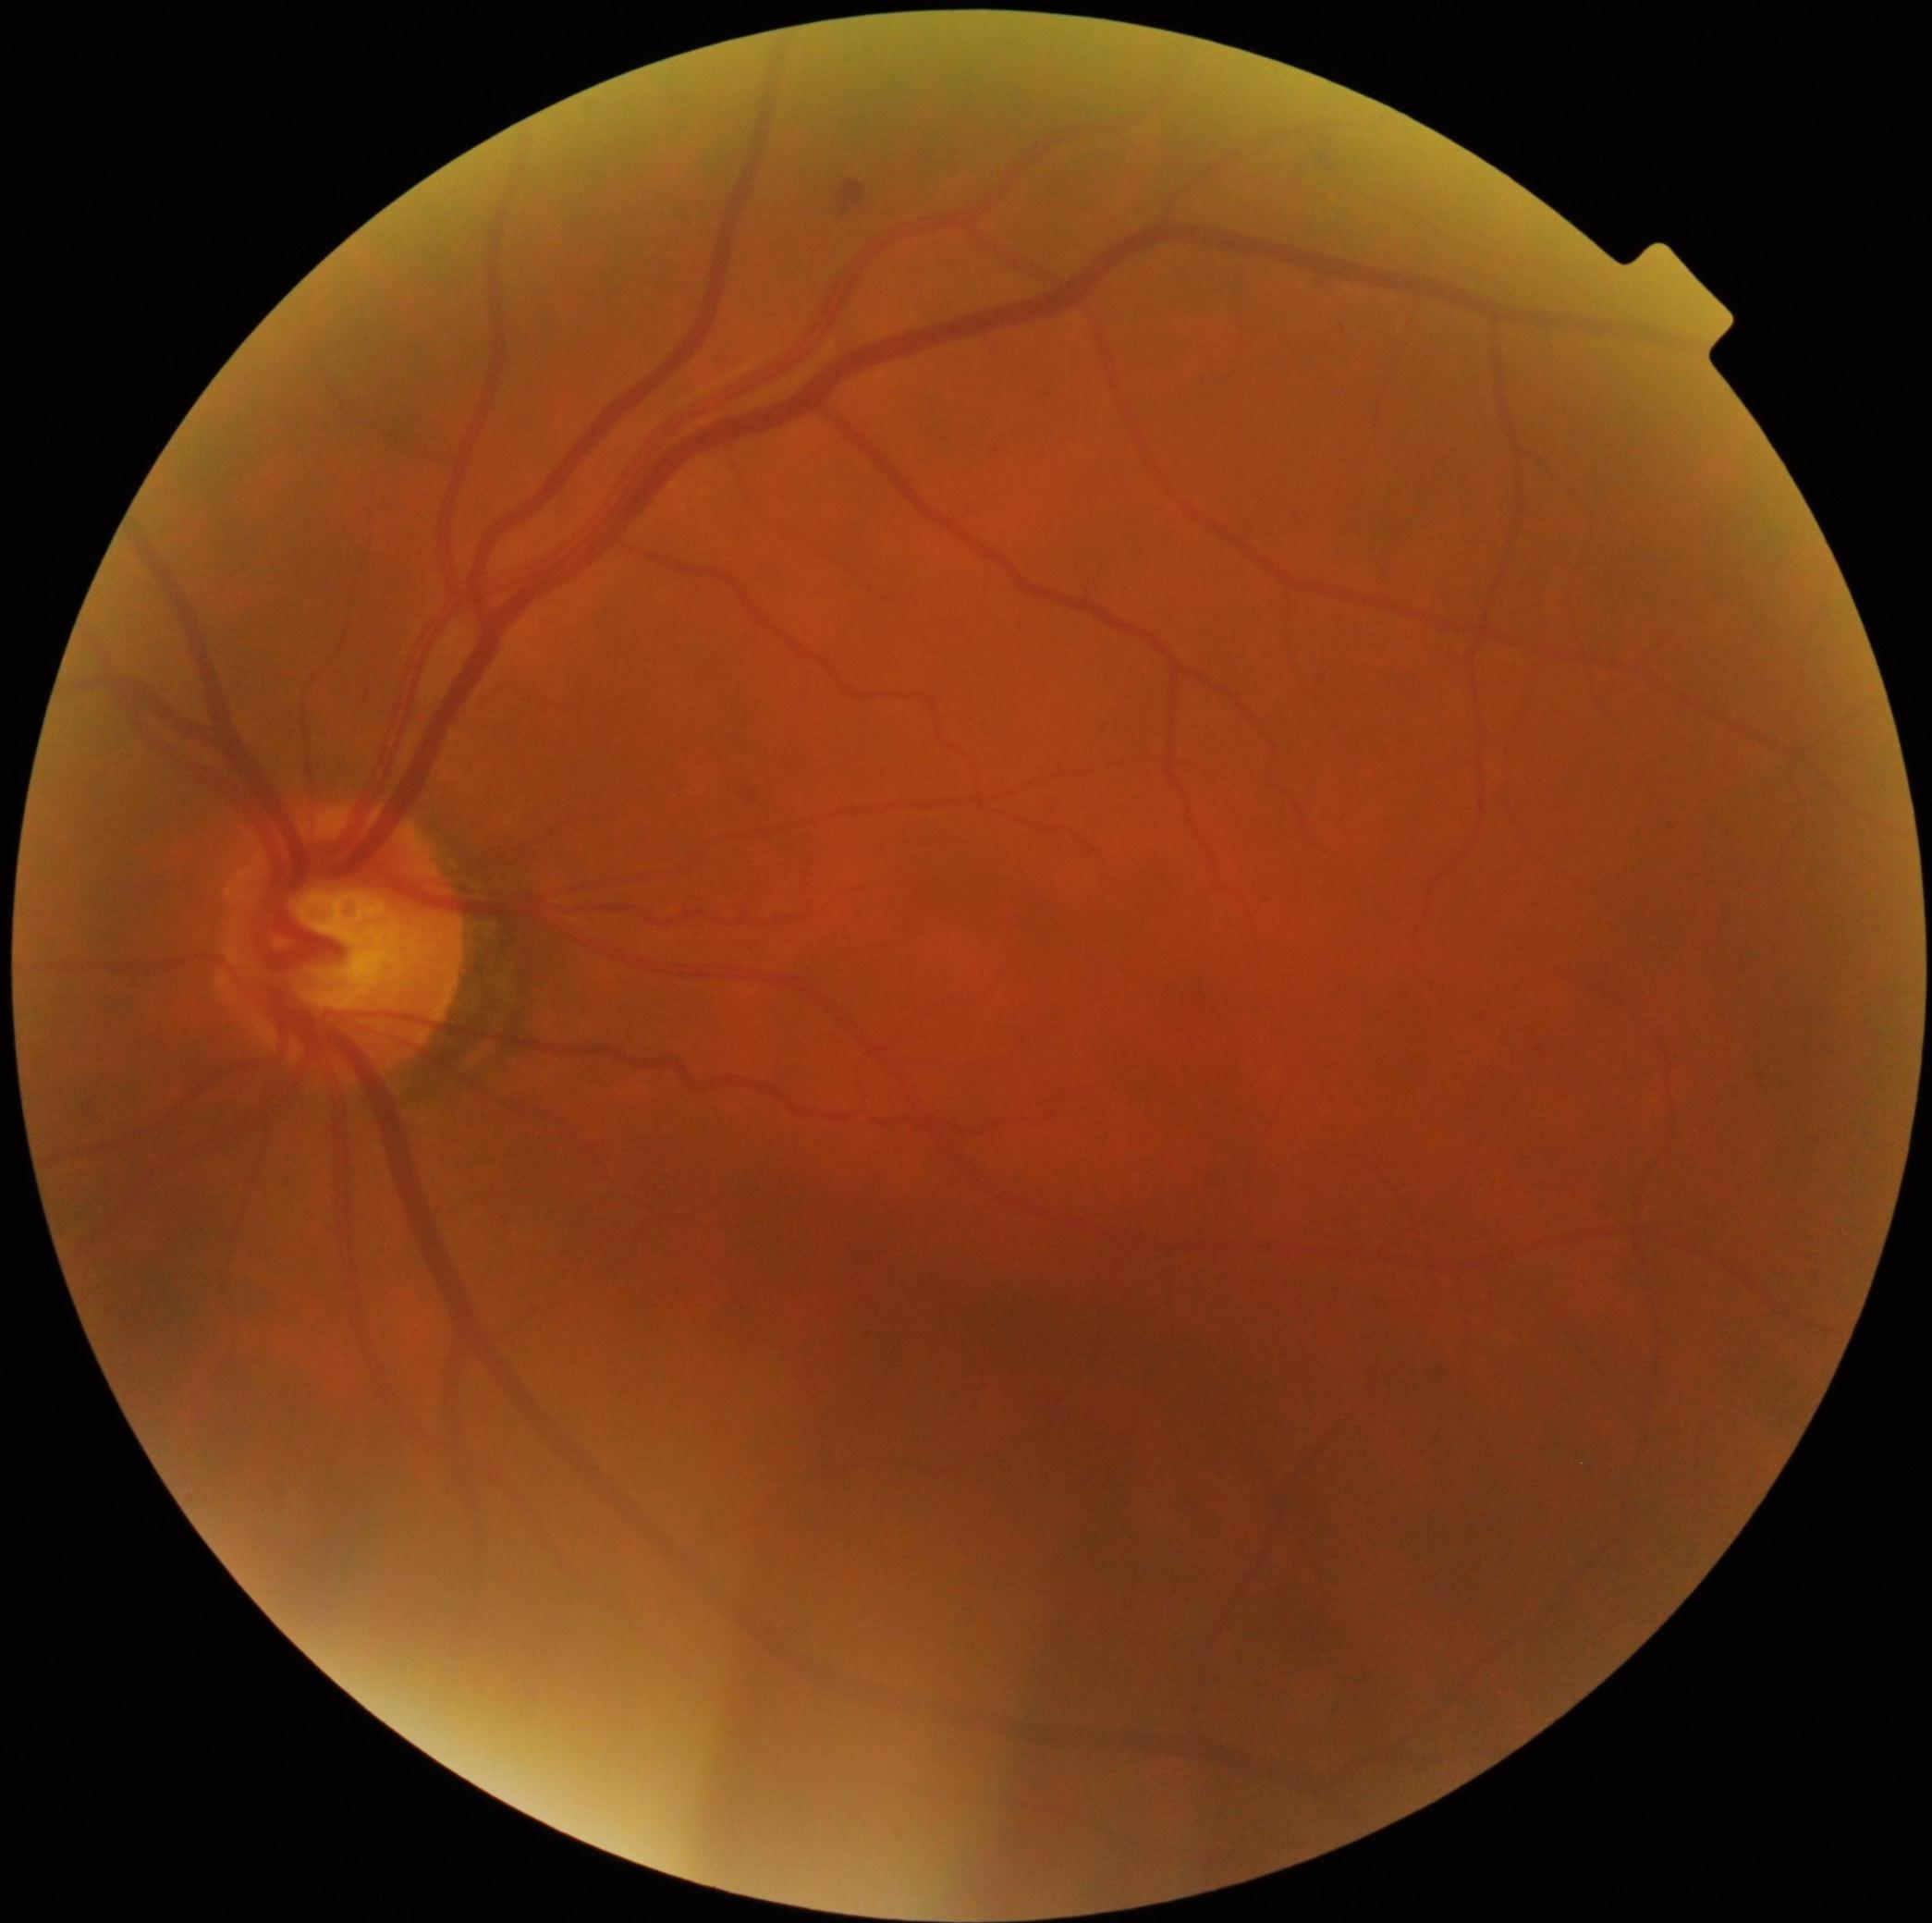 DR stage is 2/4.